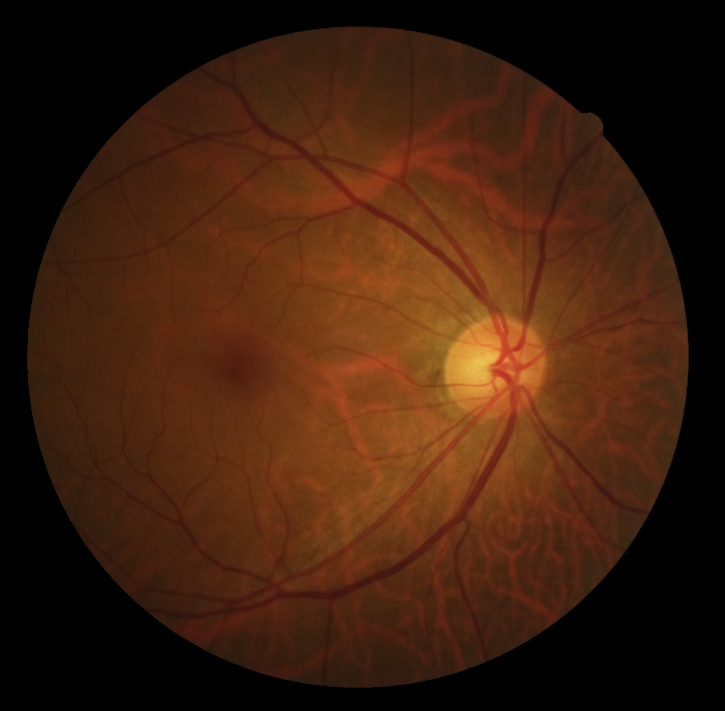
Diabetic retinopathy (DR): grade 0.